Infant wide-field fundus photograph:
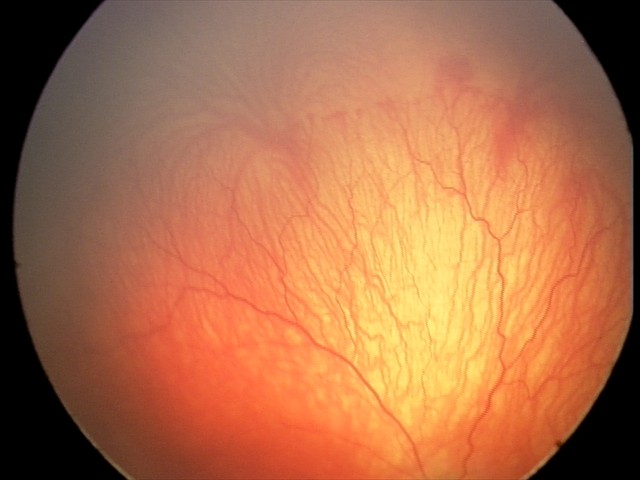

Plus disease was diagnosed.
Screening examination consistent with aggressive ROP (A-ROP).